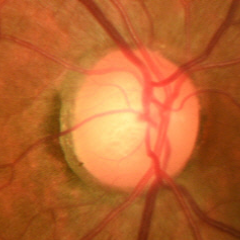 Demonstrates early glaucoma.